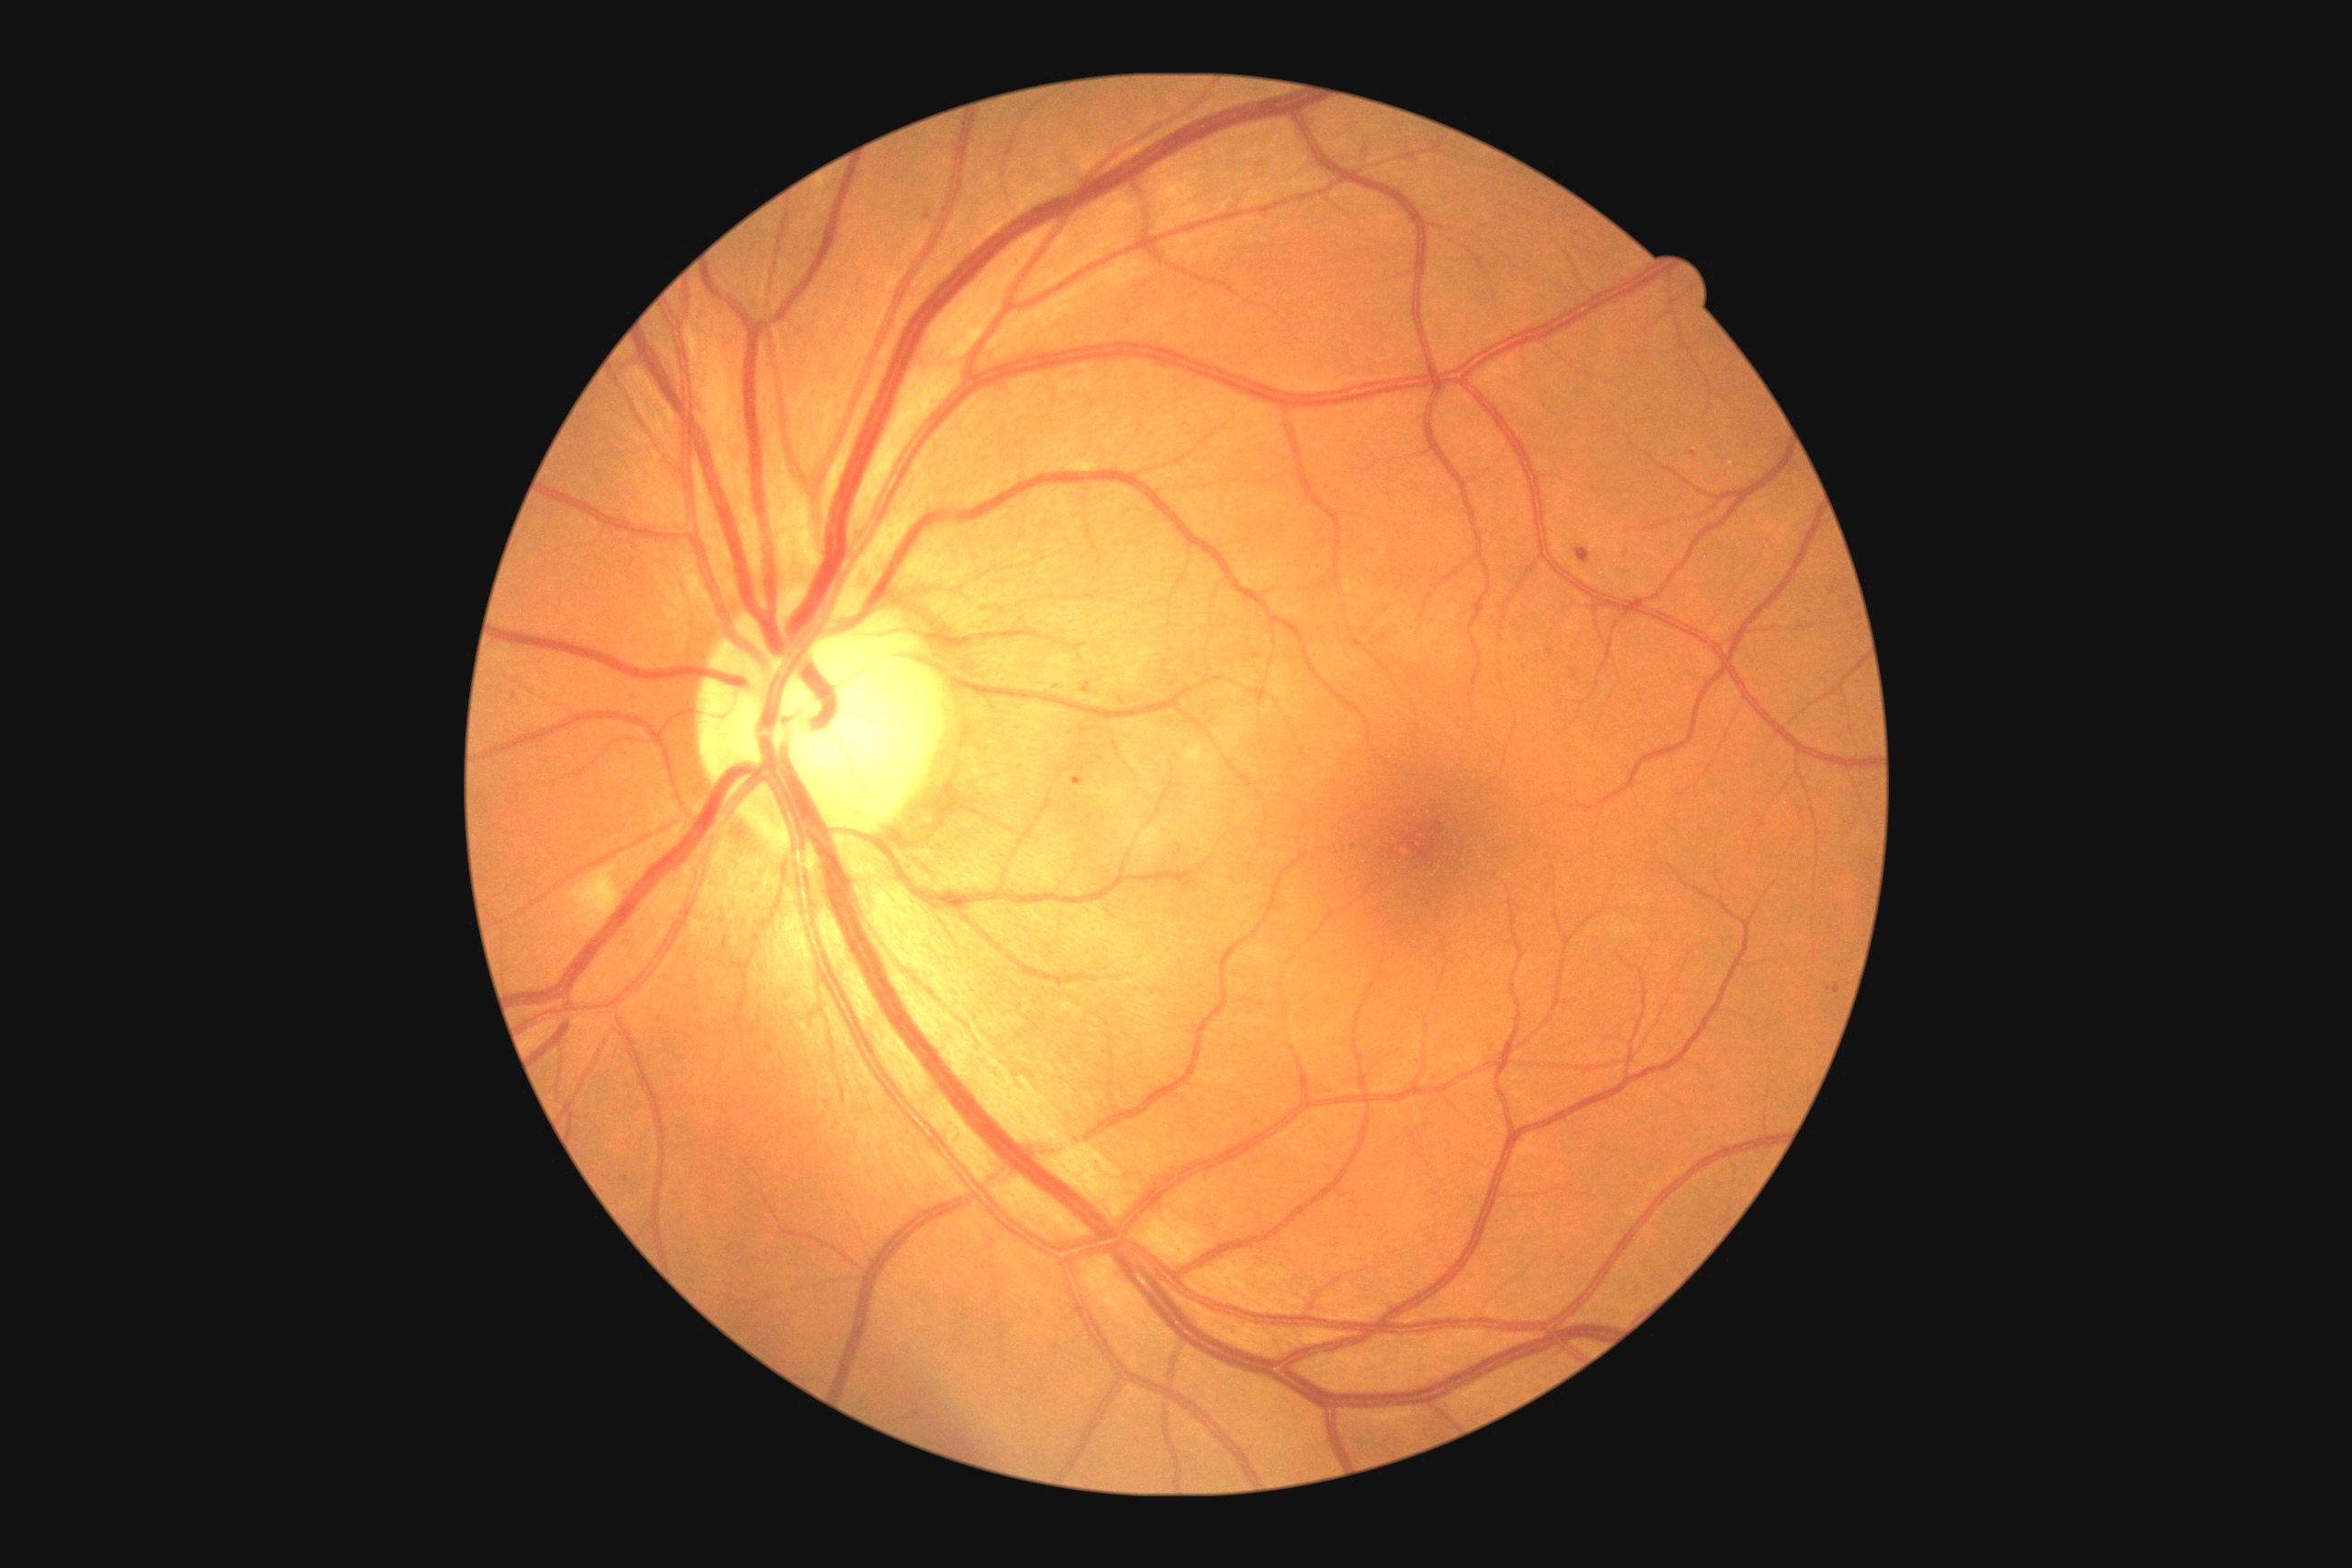

<lesions partial="true">
  <dr_grade>2</dr_grade>
  <ma partial="true">[x1=1072, y1=778, x2=1084, y2=787]; [x1=1690, y1=451, x2=1698, y2=460]; [x1=1576, y1=545, x2=1591, y2=564]; [x1=1827, y1=985, x2=1841, y2=995]; [x1=925, y1=211, x2=932, y2=220]; [x1=1083, y1=681, x2=1092, y2=694]</ma>
  <ma_small_approx>[1355, 847]; [514, 697]; [660, 1020]</ma_small_approx>
  <se>[x1=582, y1=874, x2=620, y2=926]</se>
  <he />
  <ex />
</lesions>